Infant wide-field fundus photograph:
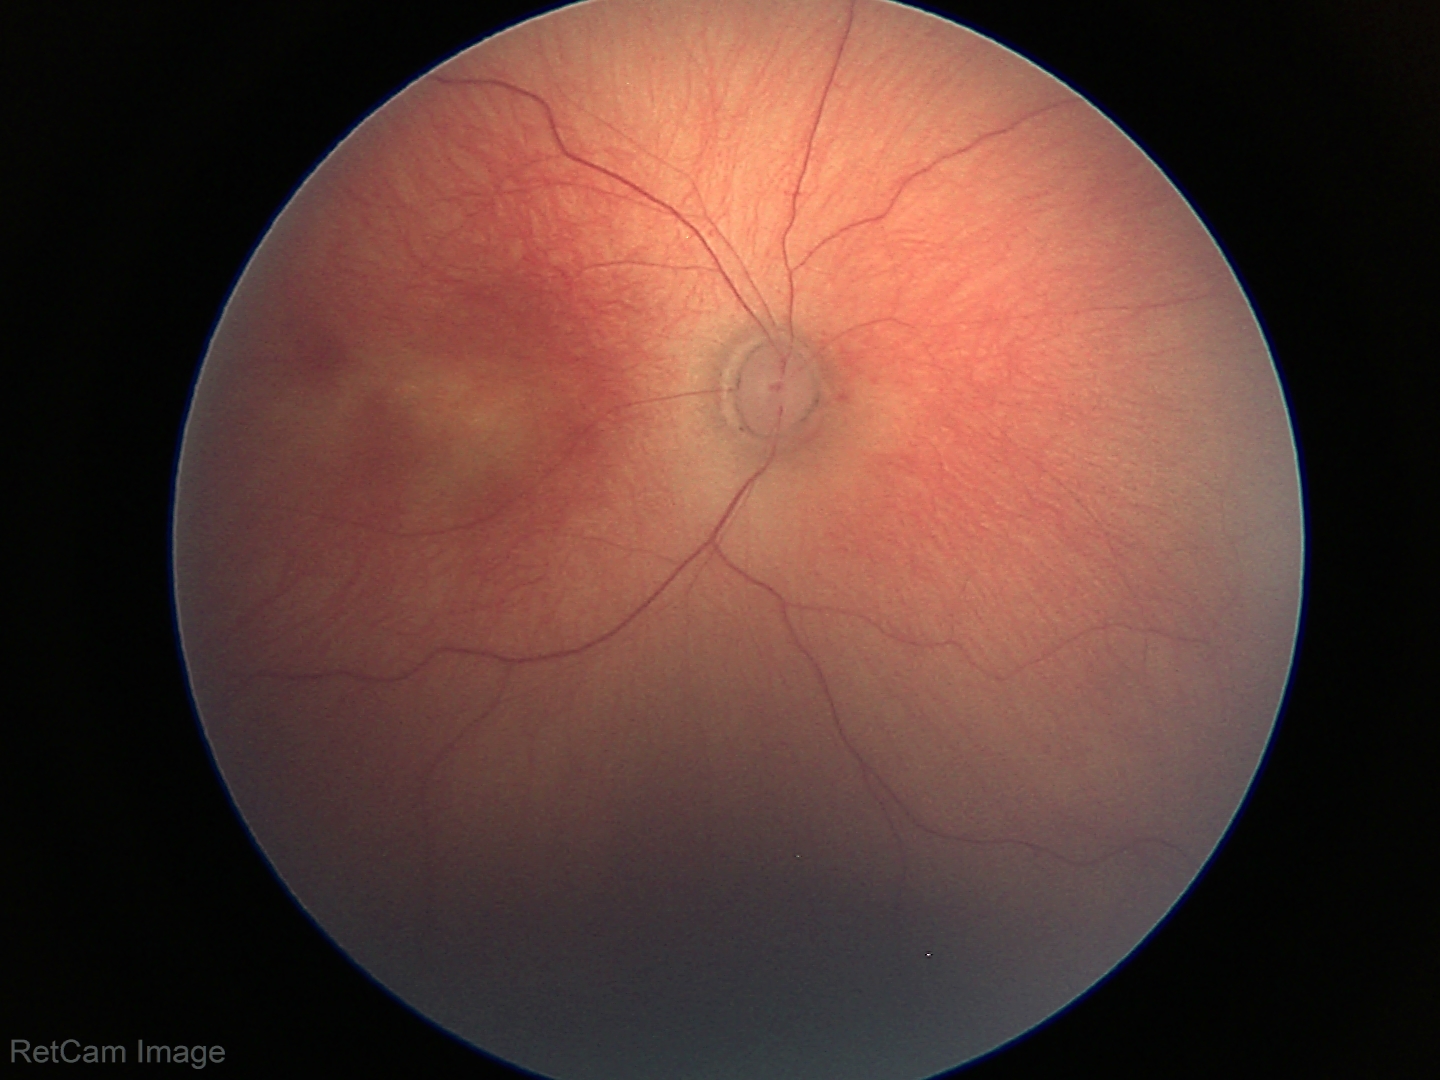 Screening examination consistent with status post ROP — retinal appearance after treated retinopathy of prematurity.
Without plus disease.